45° field of view. Color fundus photograph. 2352x1568px
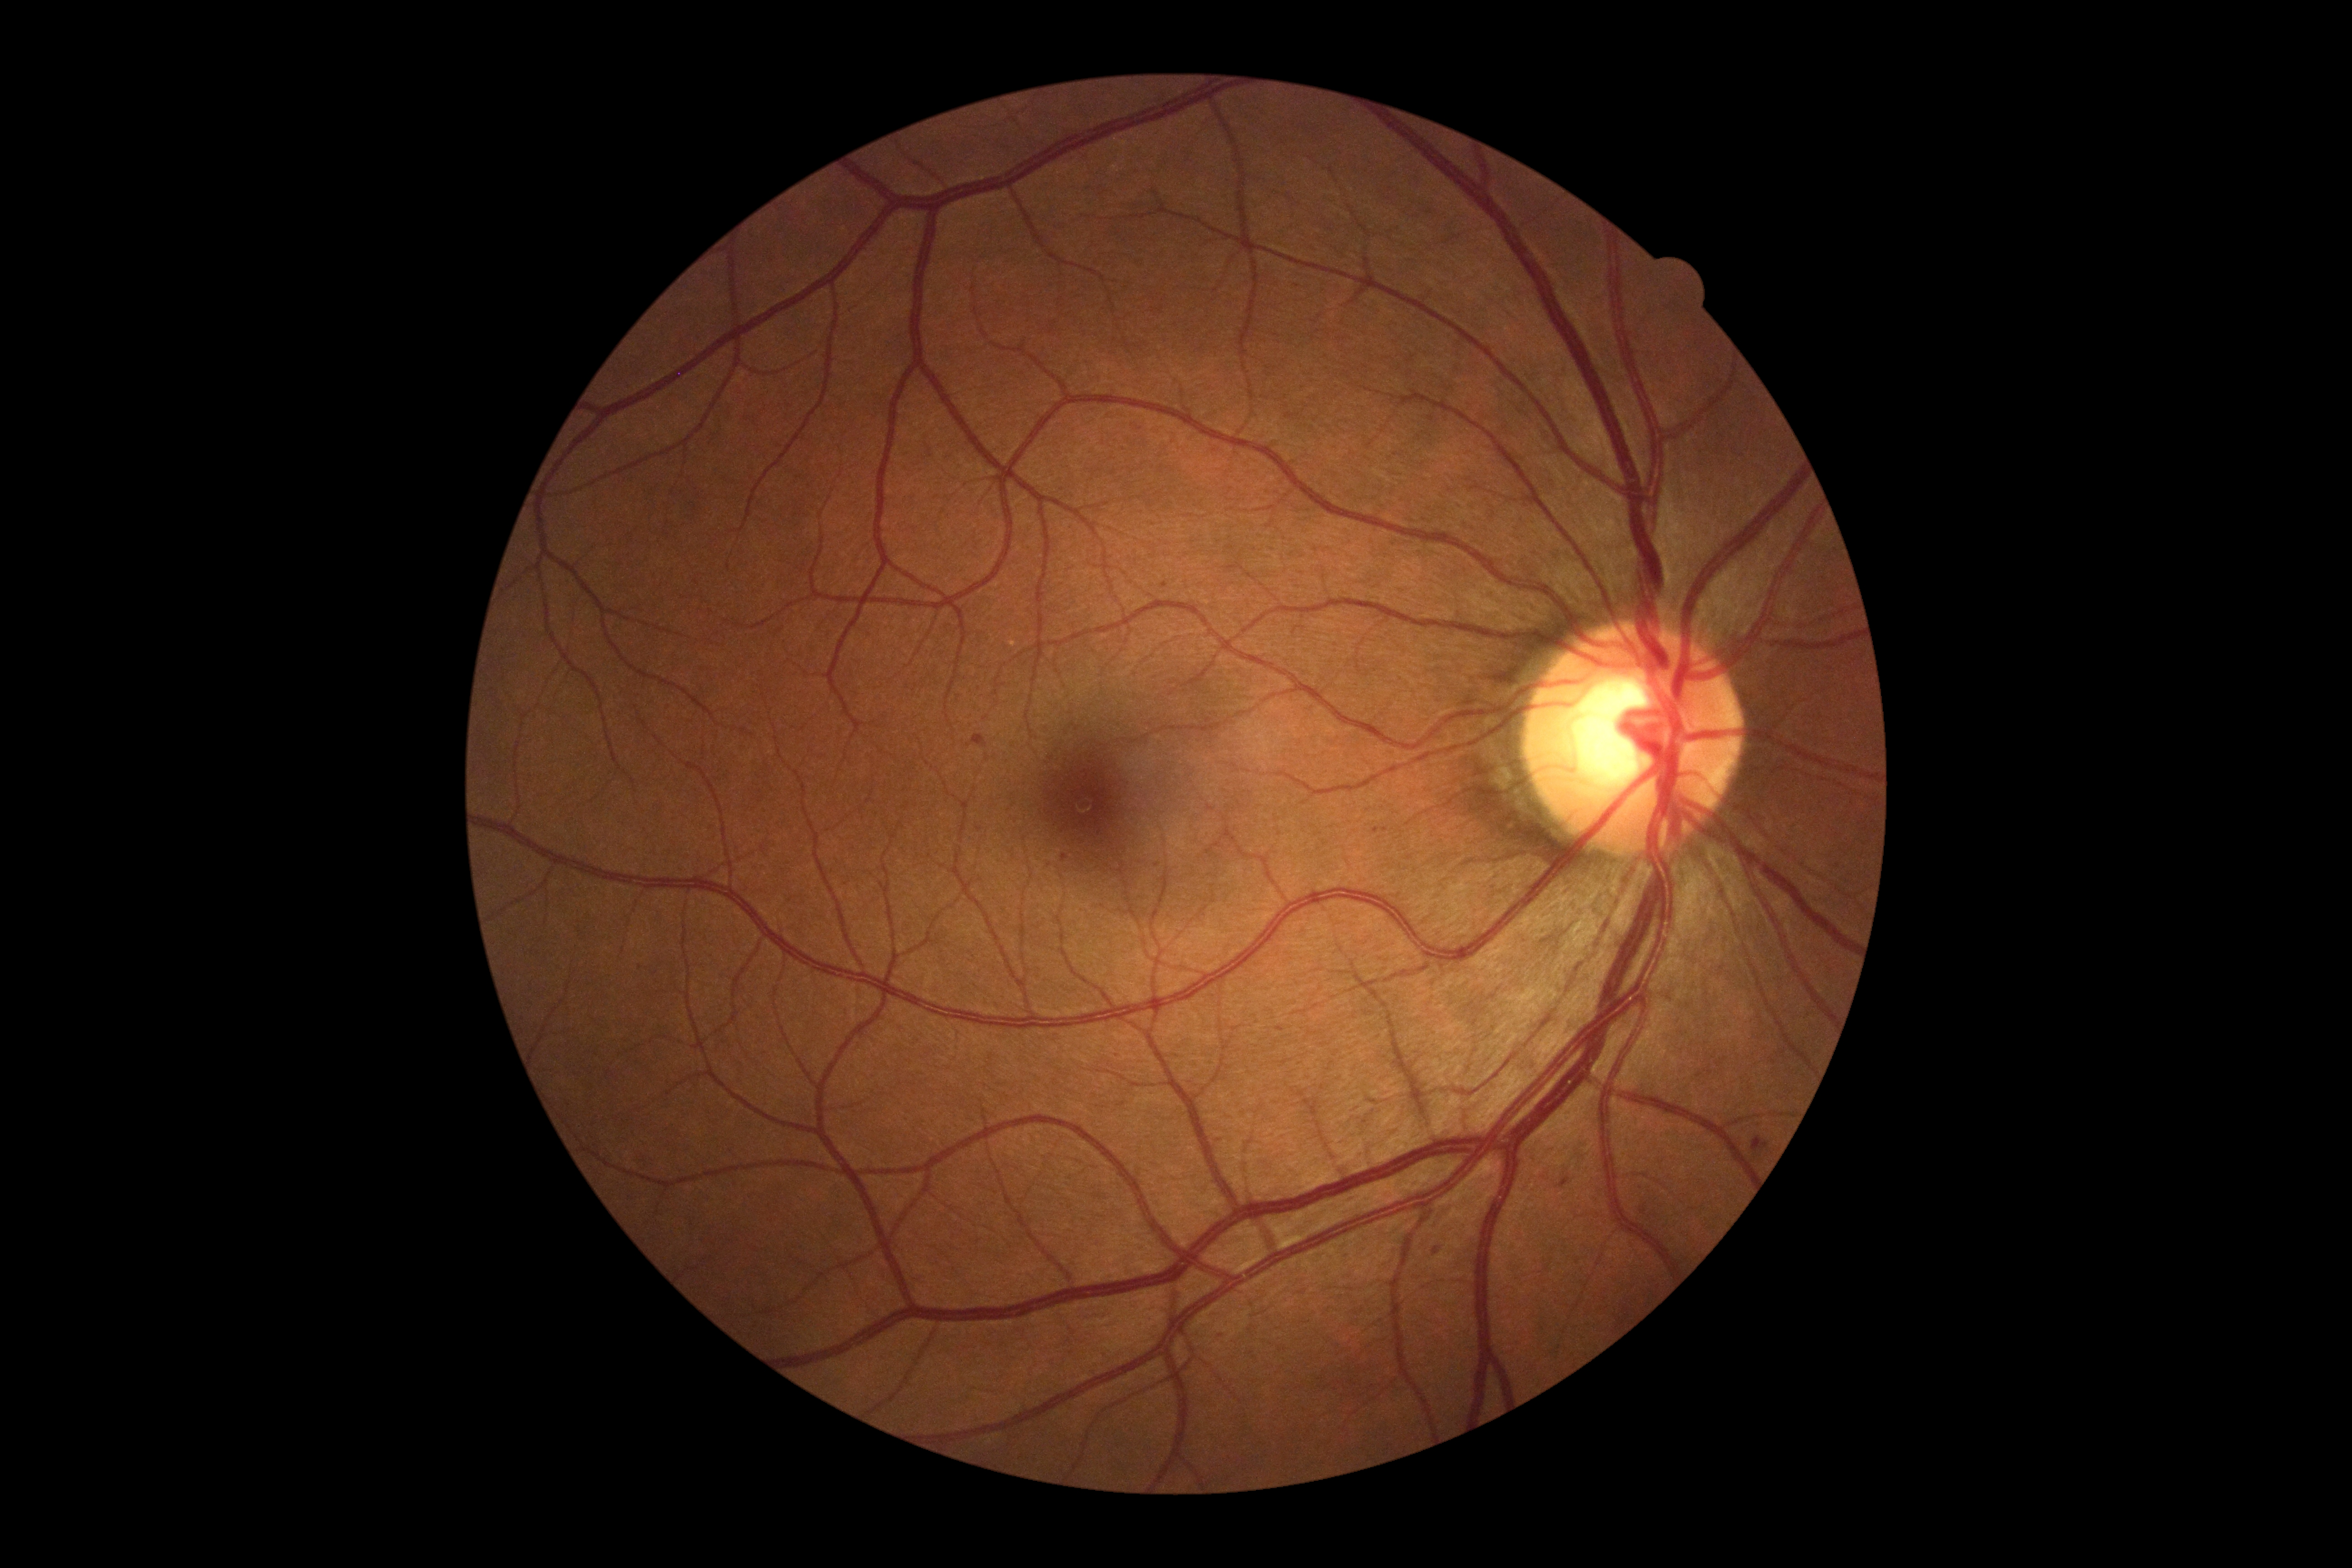

DR: moderate non-proliferative diabetic retinopathy (grade 2). Disease class: non-proliferative diabetic retinopathy.